Acquired with a NIDEK AFC-230. Nonmydriatic. Diabetic retinopathy graded by the modified Davis classification.
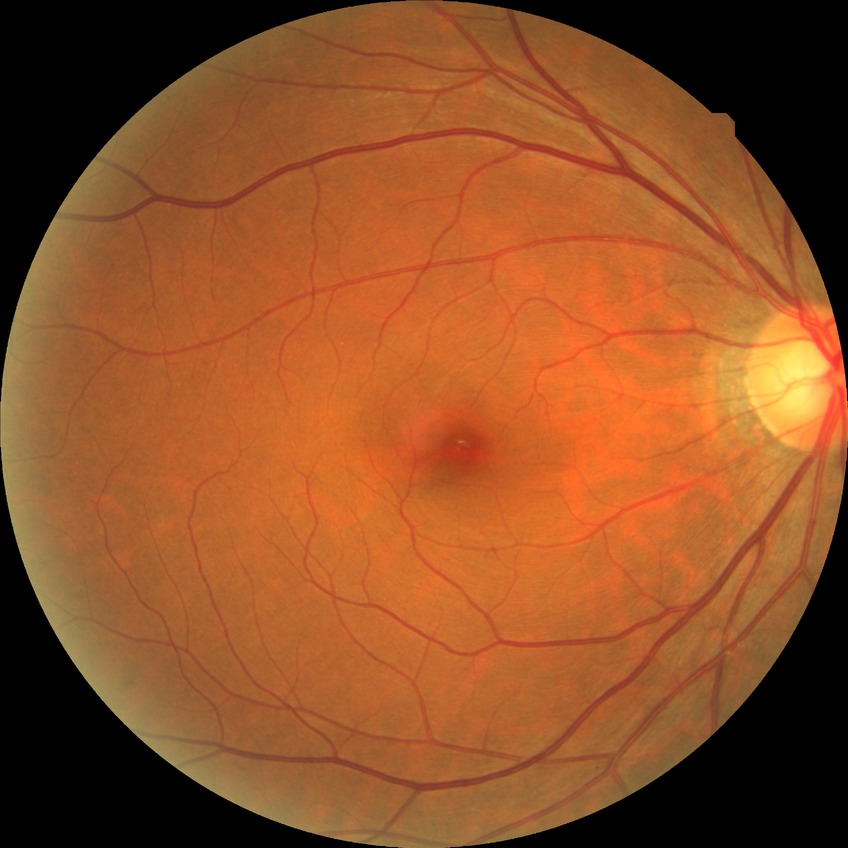

diabetic retinopathy (DR): no diabetic retinopathy (NDR).